45-degree field of view. Fundus photo.
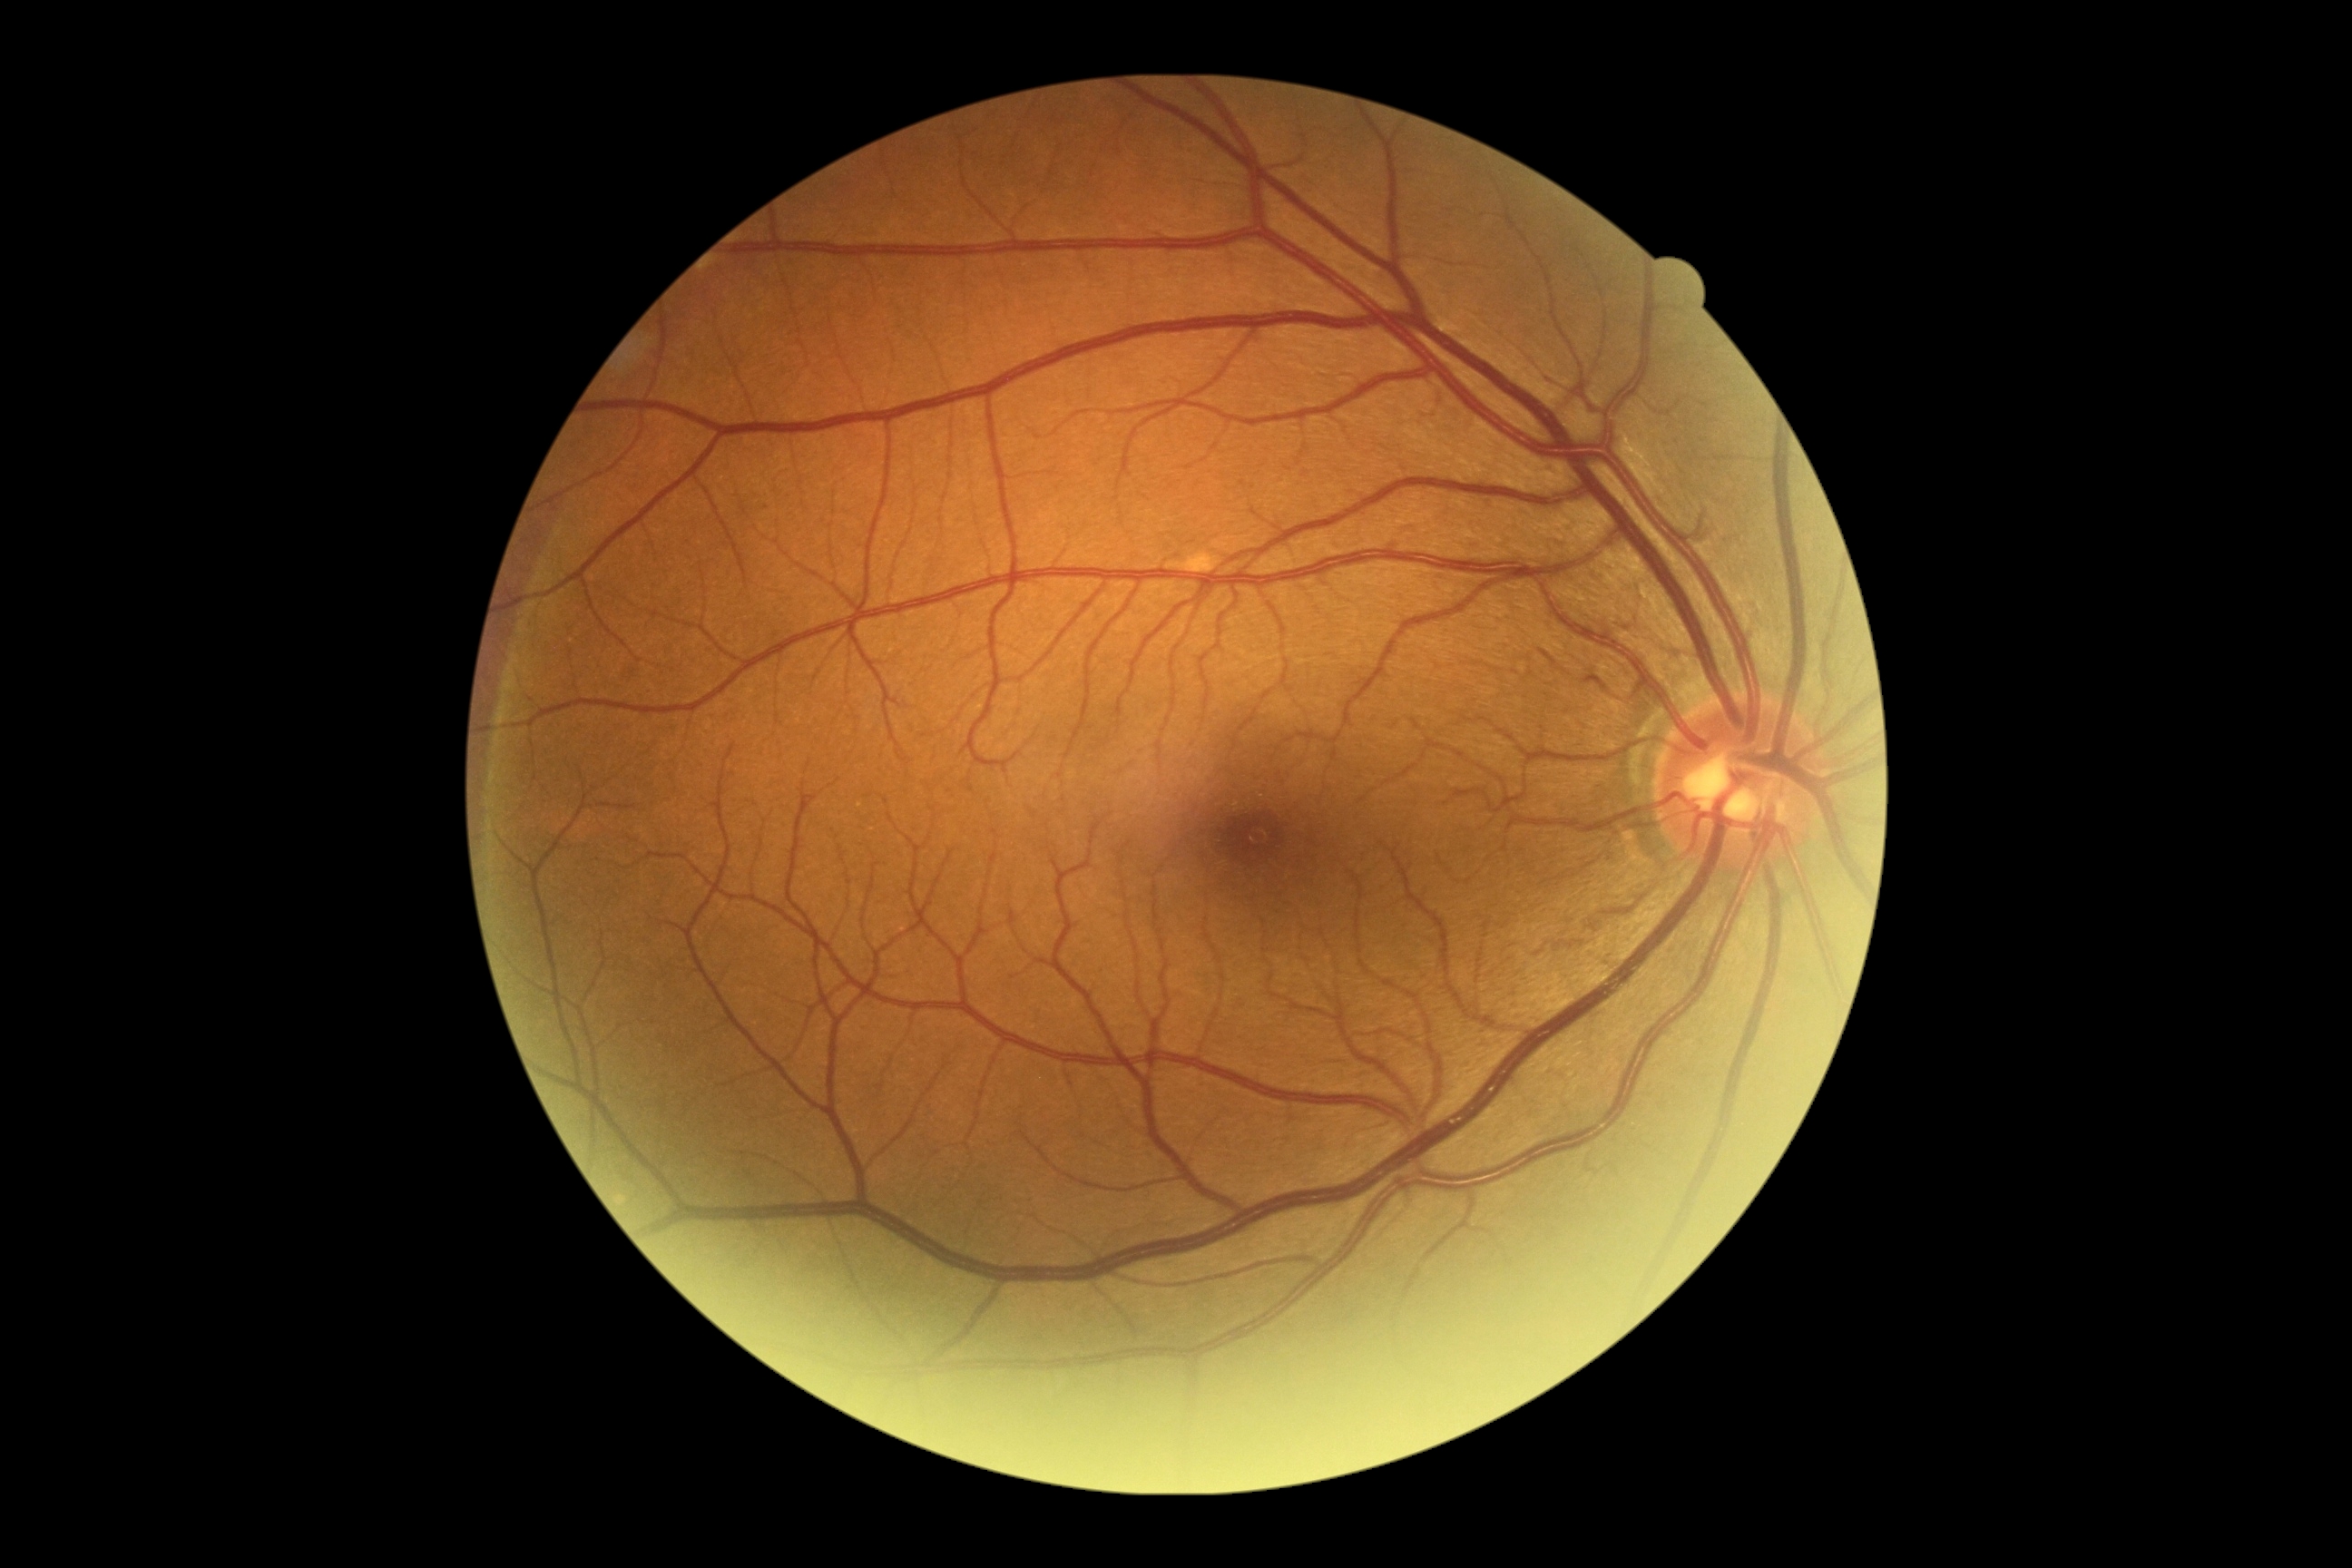
Diabetic retinopathy (DR) is grade 0.